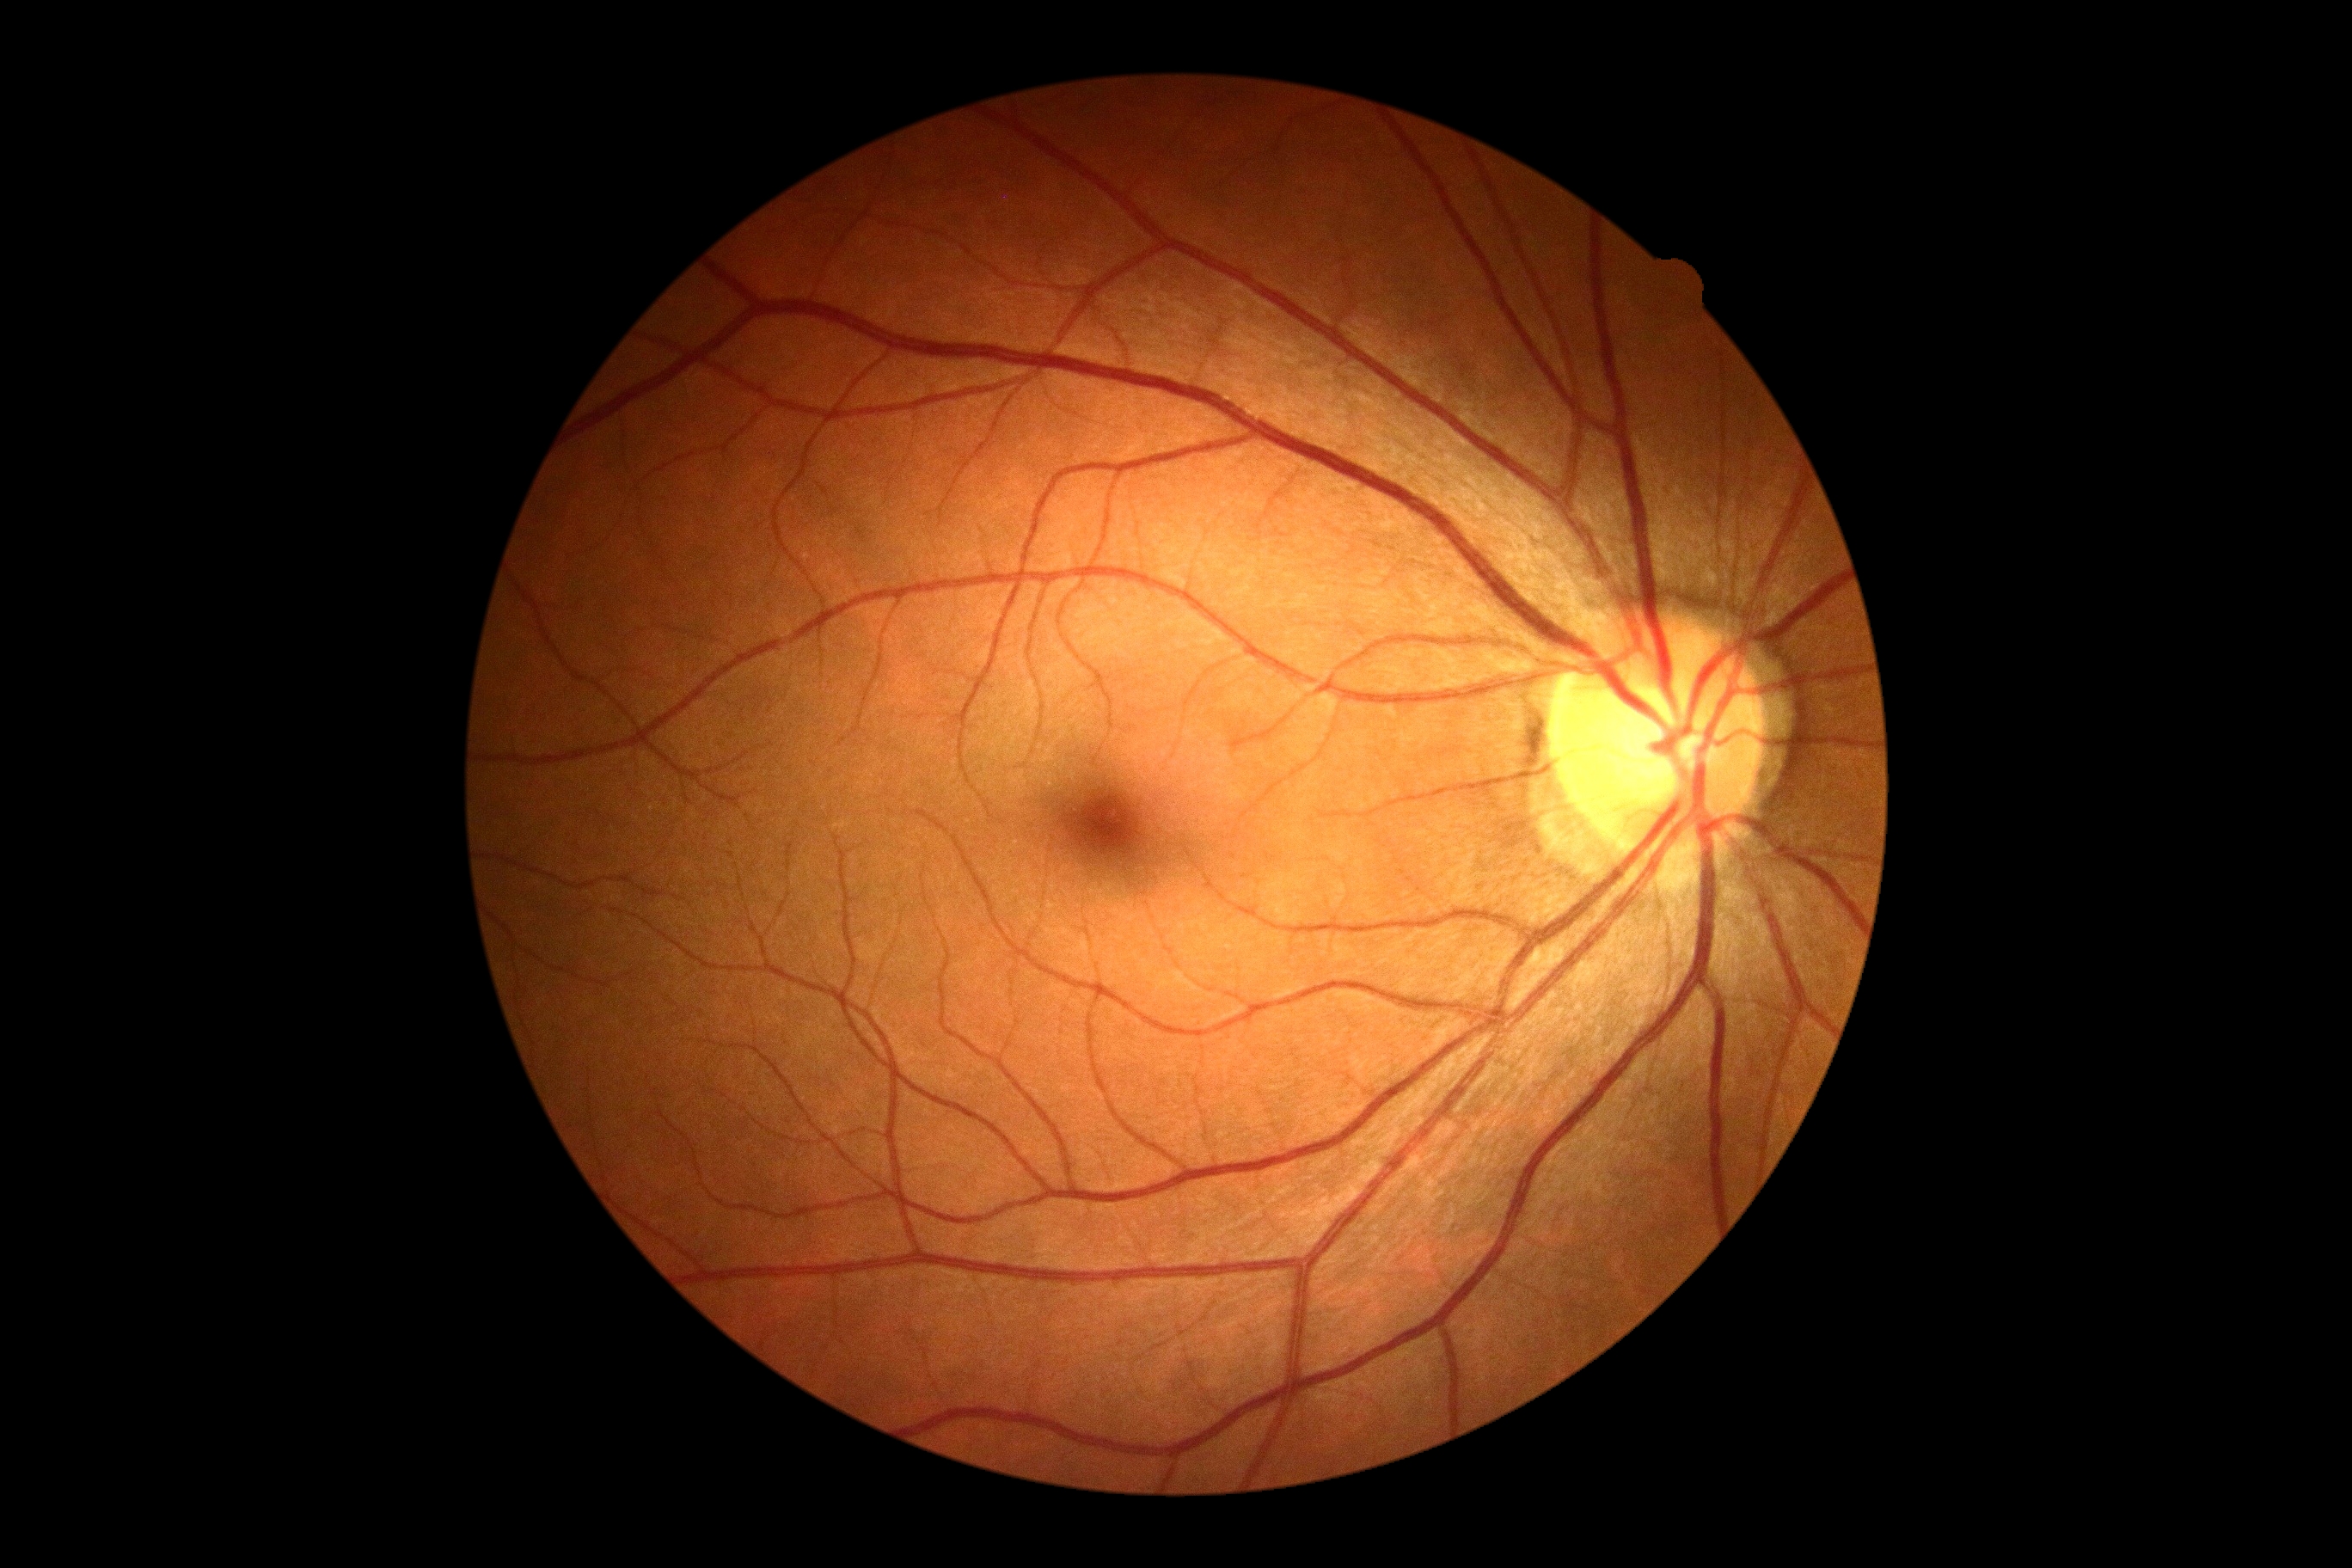

No diabetic retinal disease findings. DR stage is grade 0 (no apparent retinopathy).